CFP:
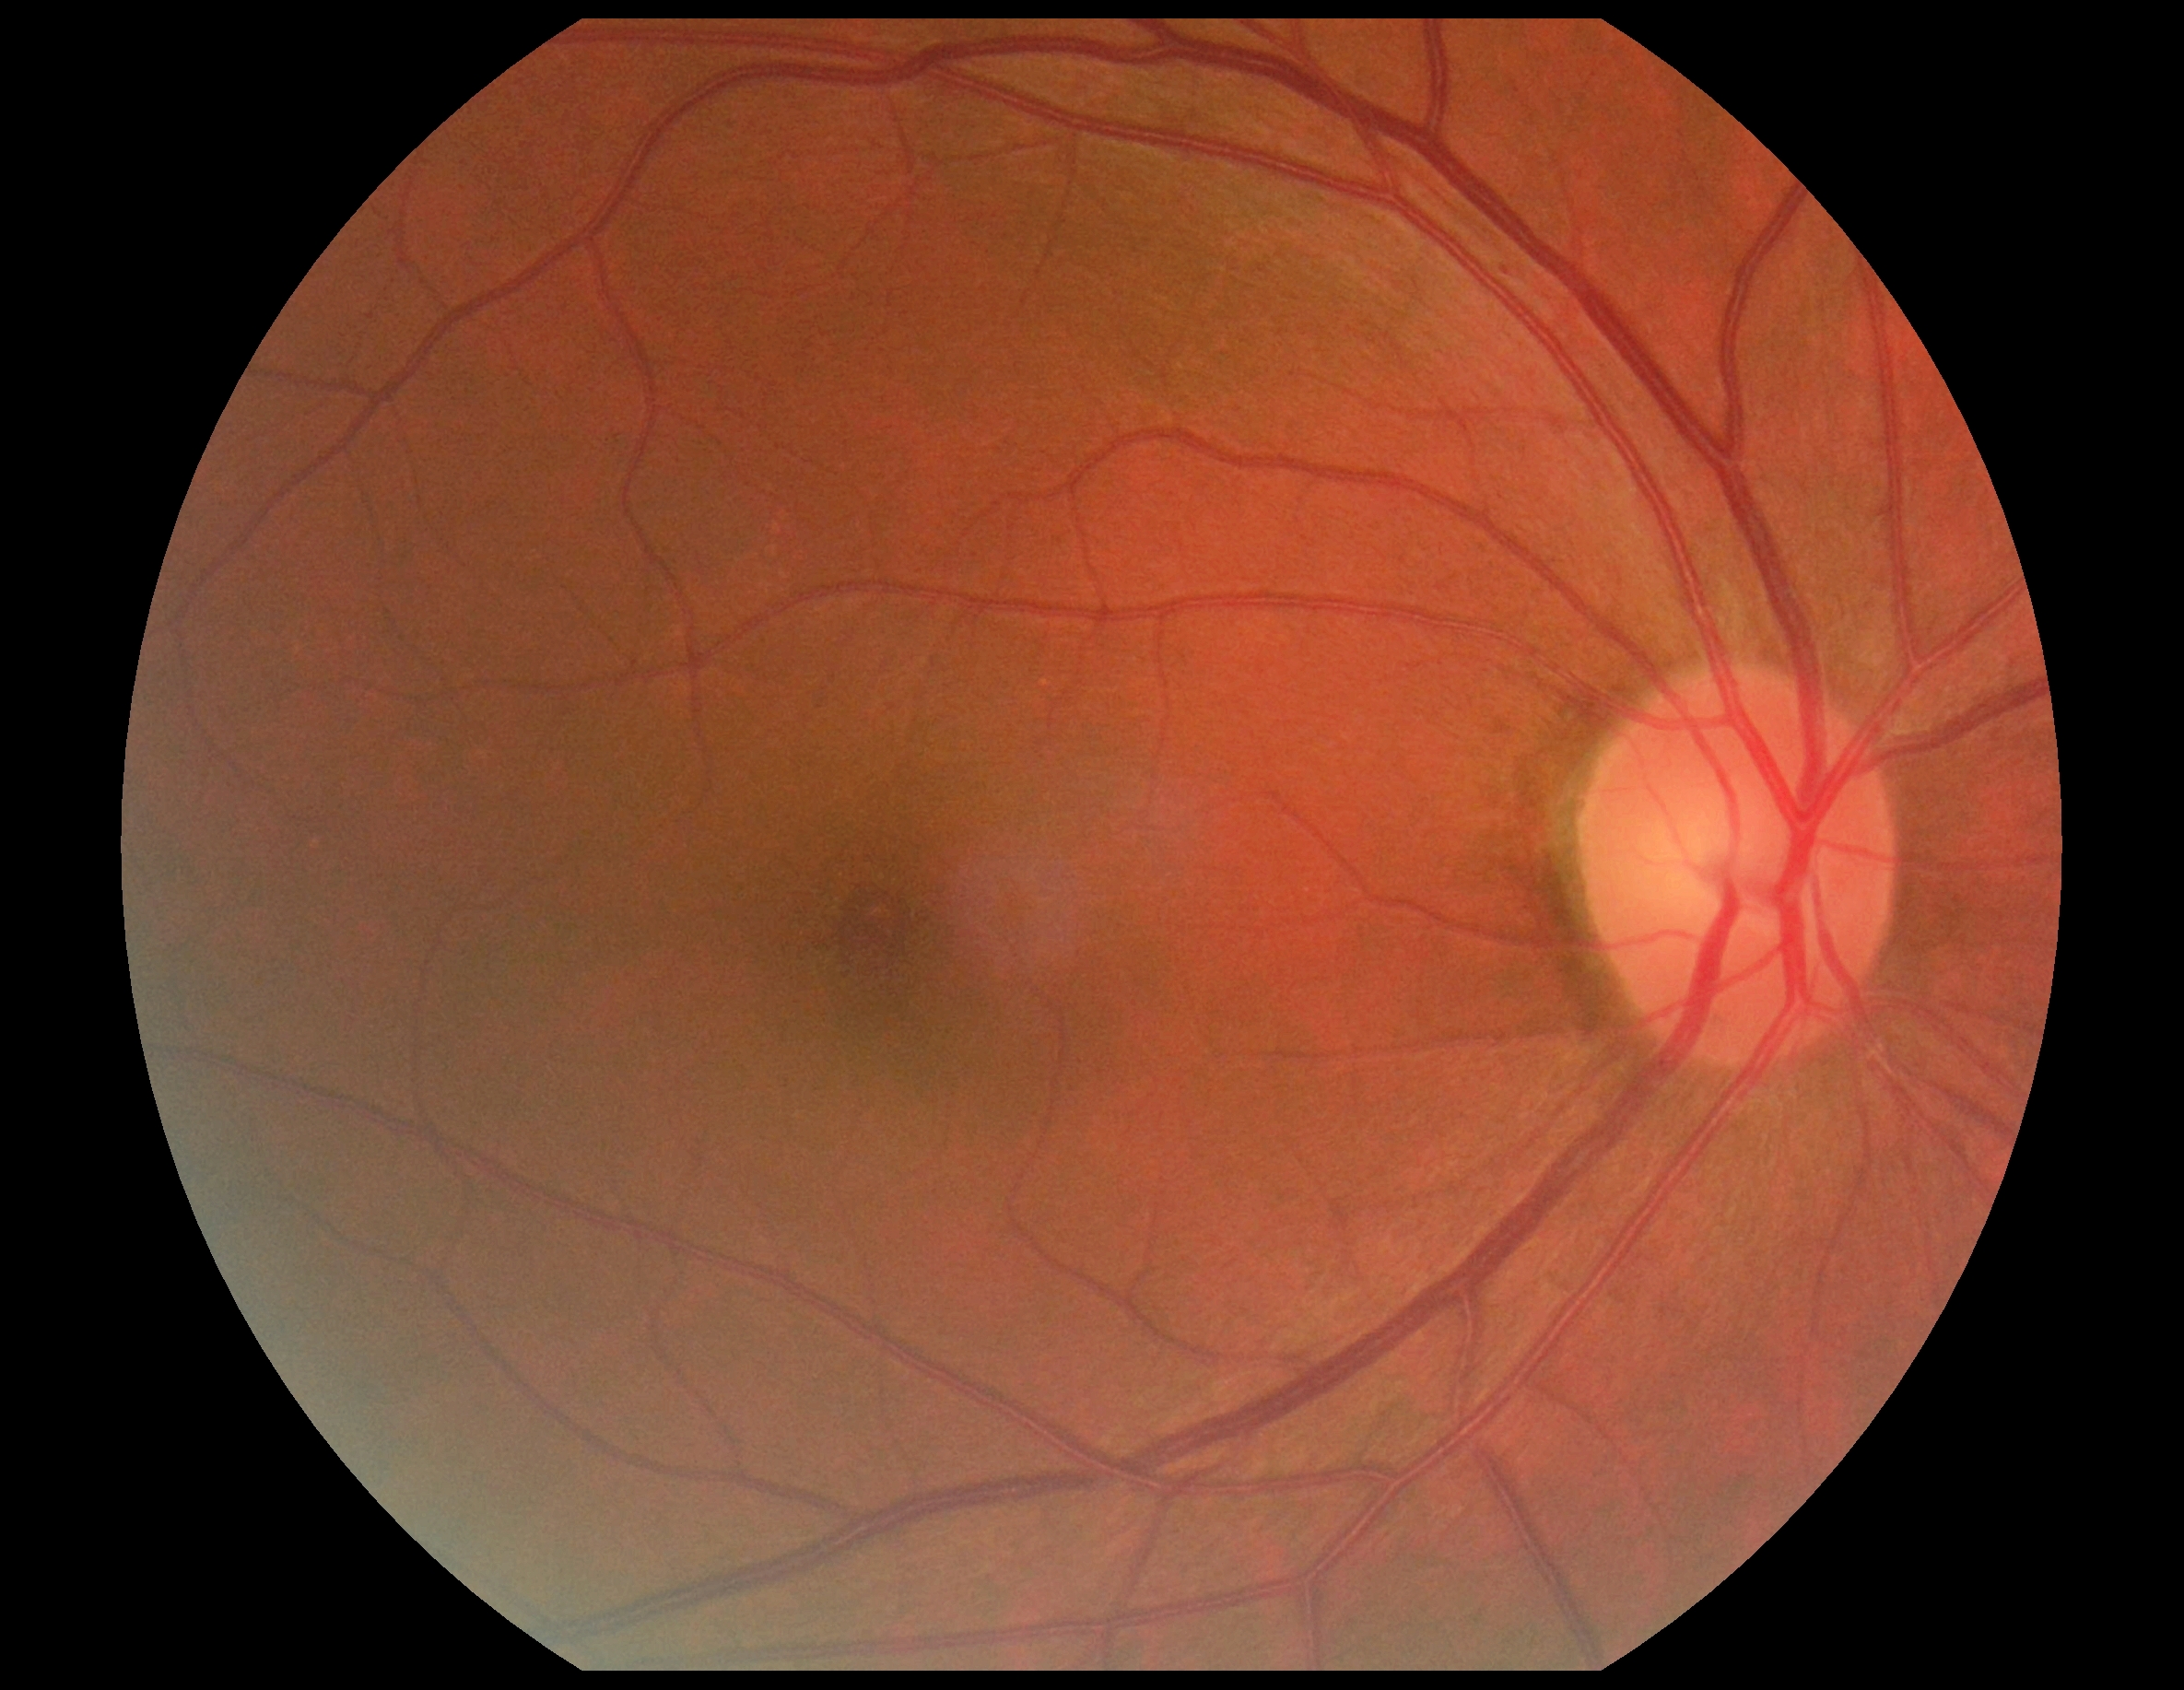

DR severity is grade 1 (mild NPDR).